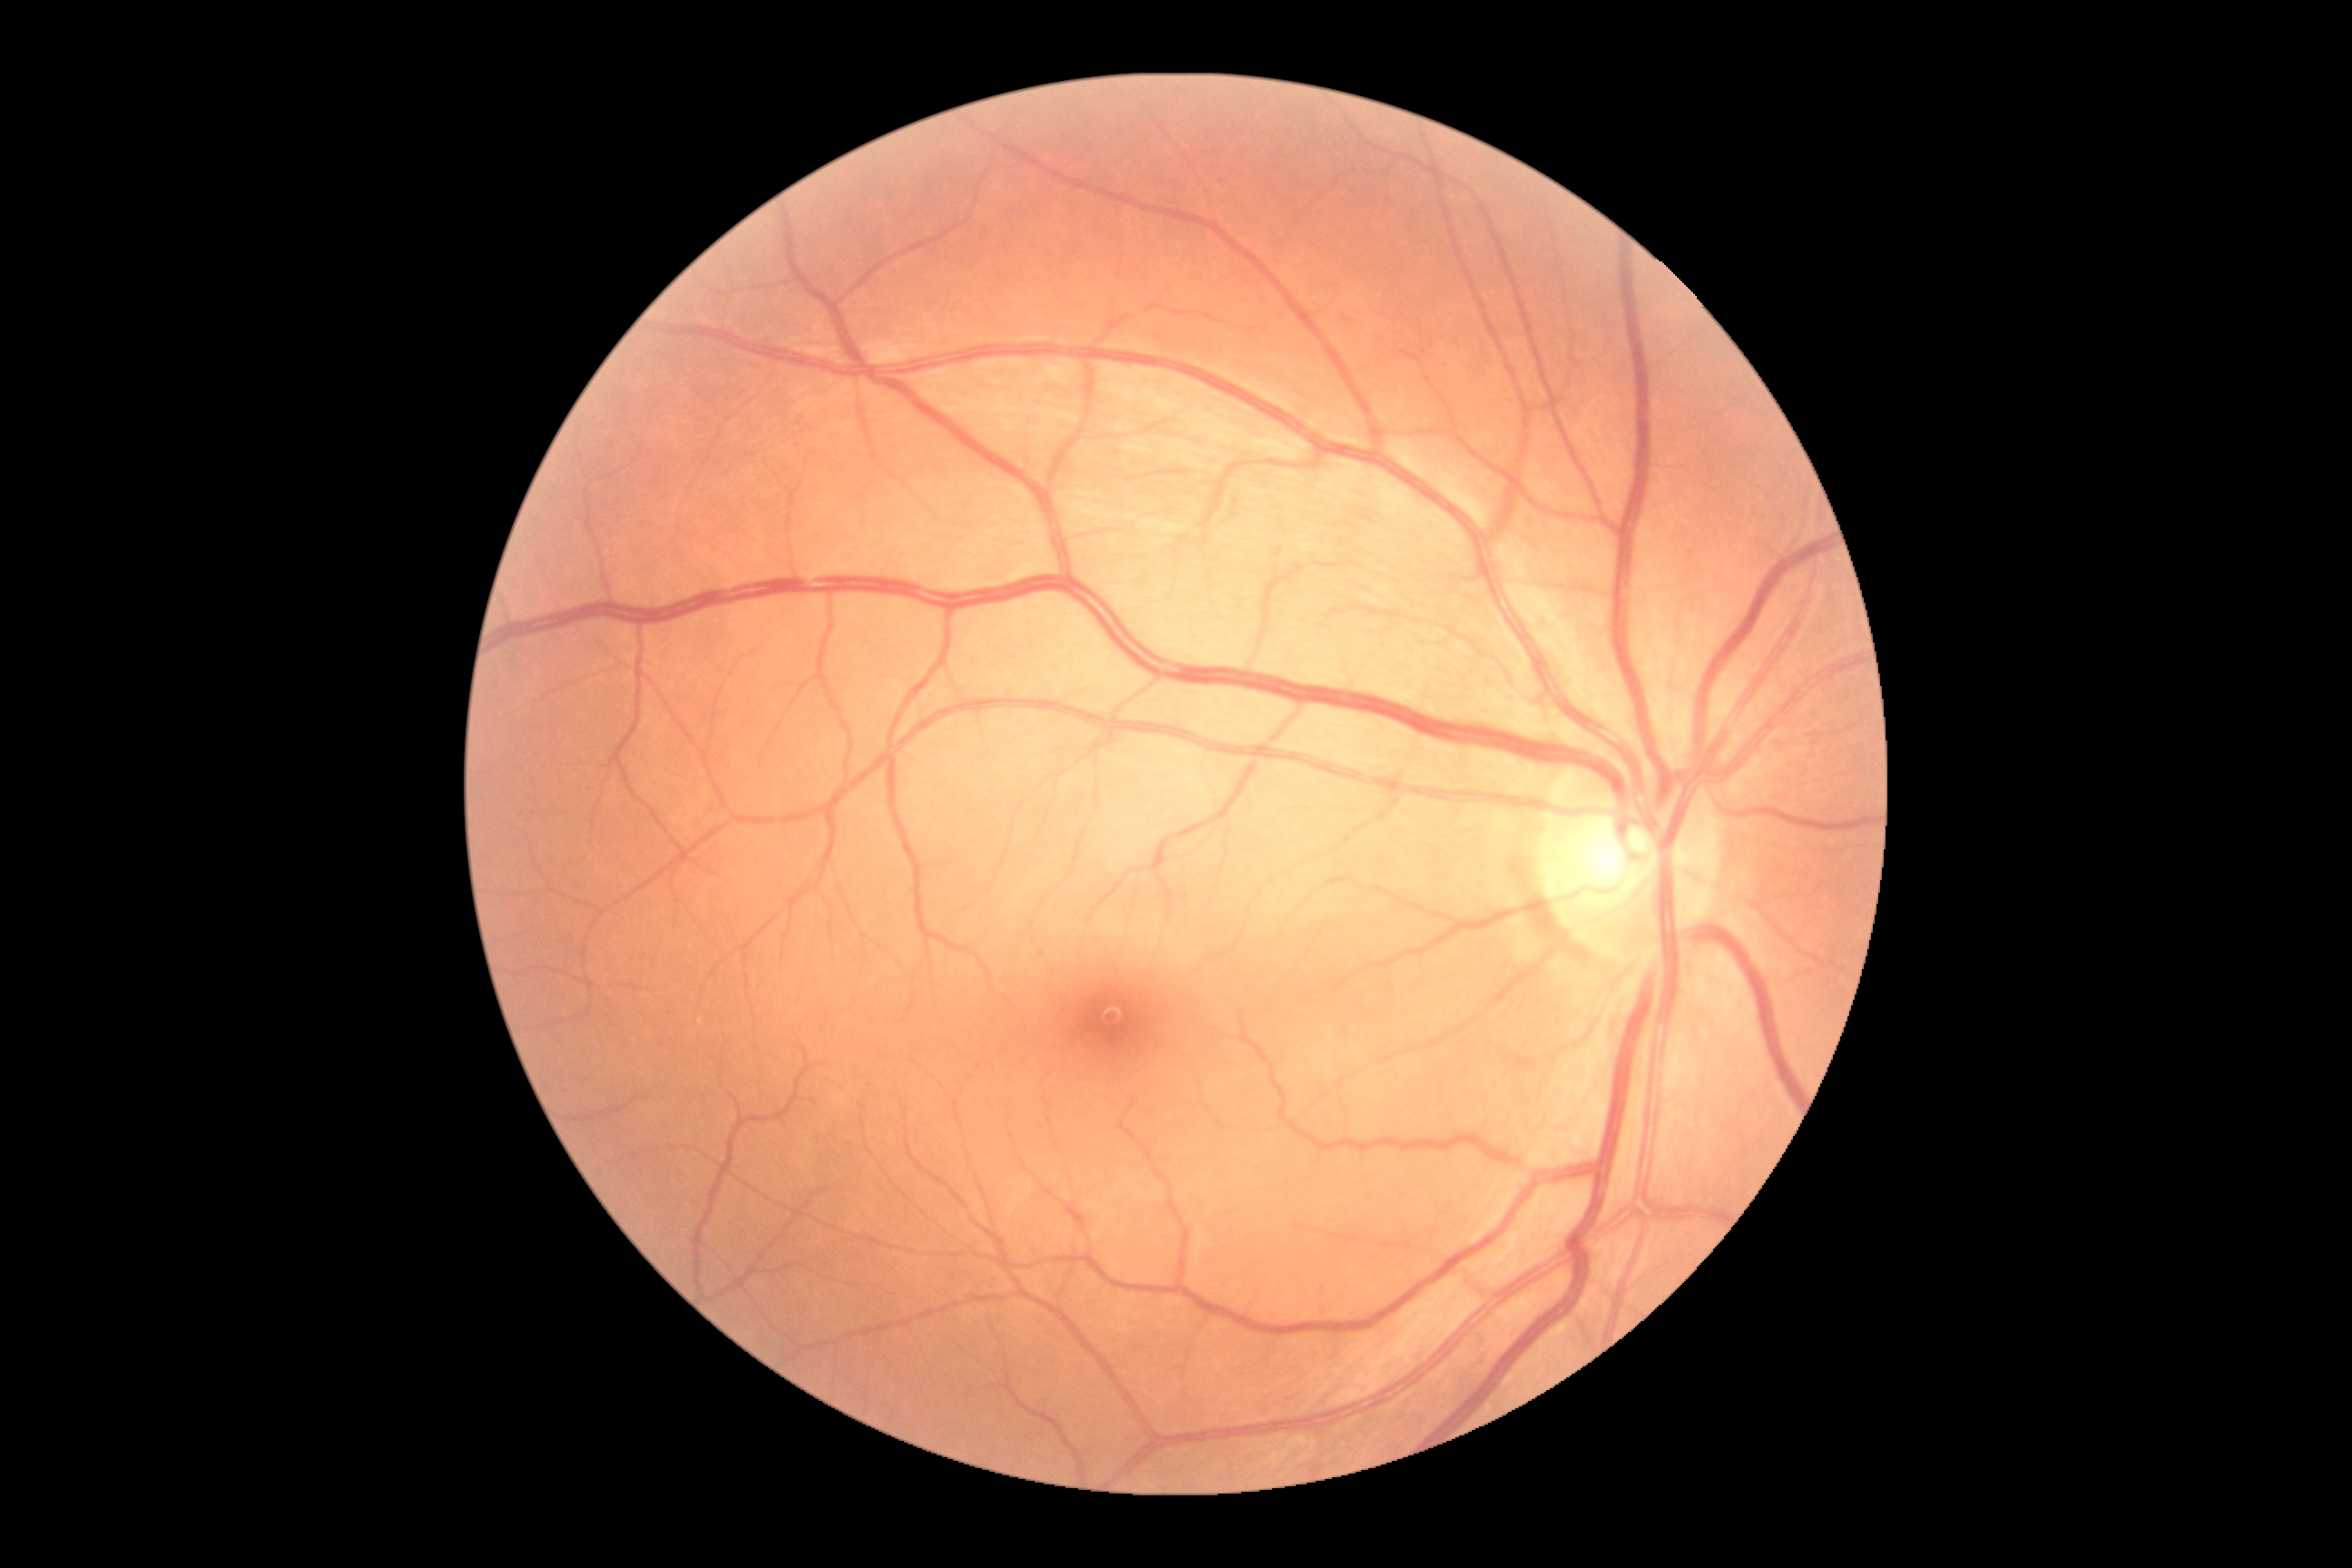
diabetic retinopathy grade: 0.